Image size 1440x1080; pediatric retinal photograph (wide-field); camera: Natus RetCam Envision (130° FOV)
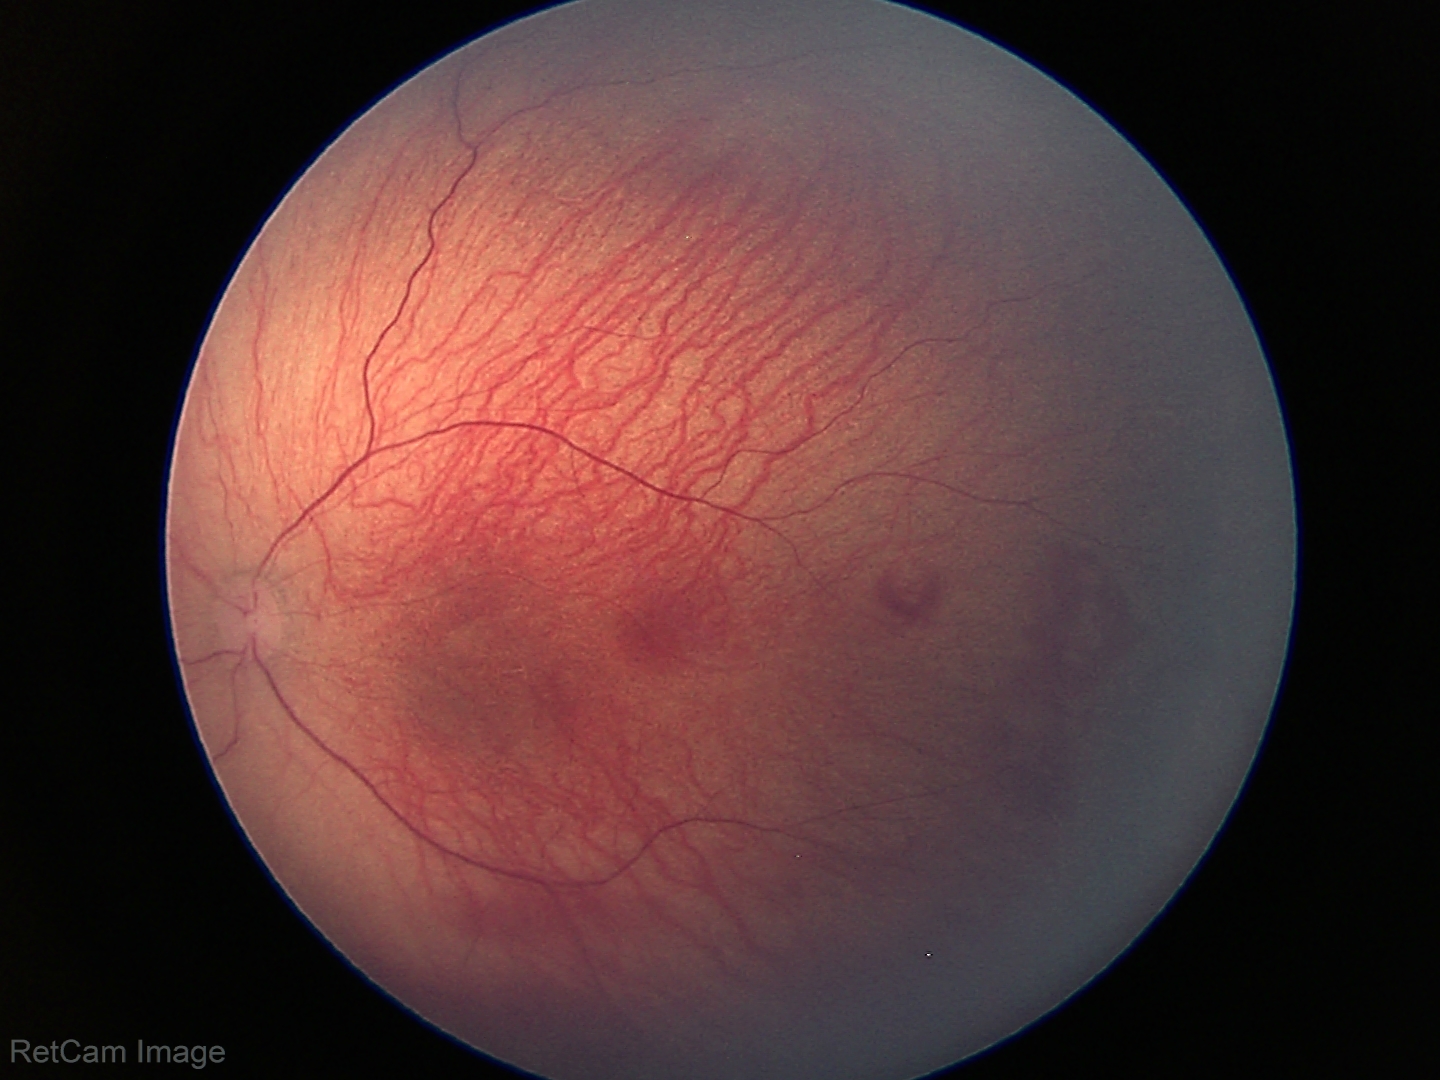 Retinopathy of prematurity (ROP) stage: 1 — demarcation line between vascular and avascular retina
plus form: absent